Pediatric wide-field fundus photograph · Clarity RetCam 3, 130° FOV.
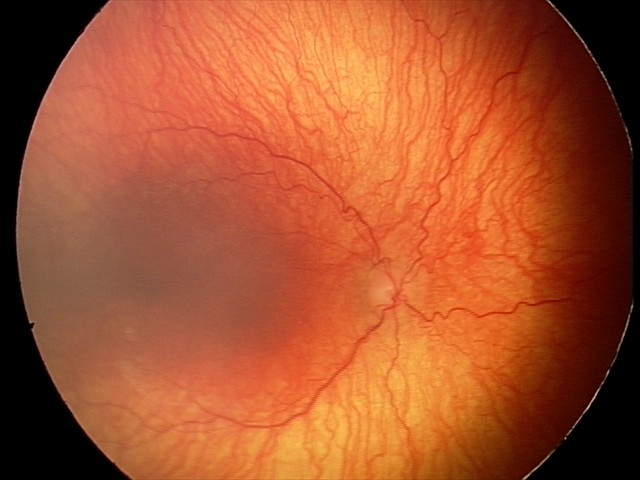 Plus disease: present
diagnosis: aggressive retinopathy of prematurity — rapidly progressive severe ROP with prominent plus disease, often without classic stage progression